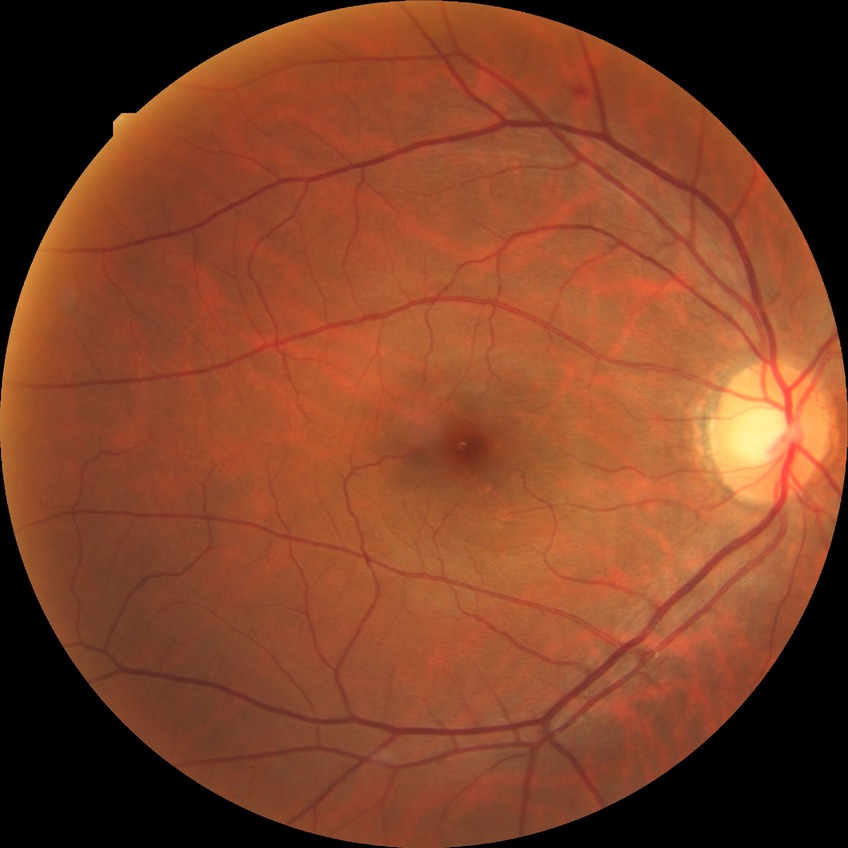
Diabetic retinopathy (DR) is simple diabetic retinopathy (SDR).